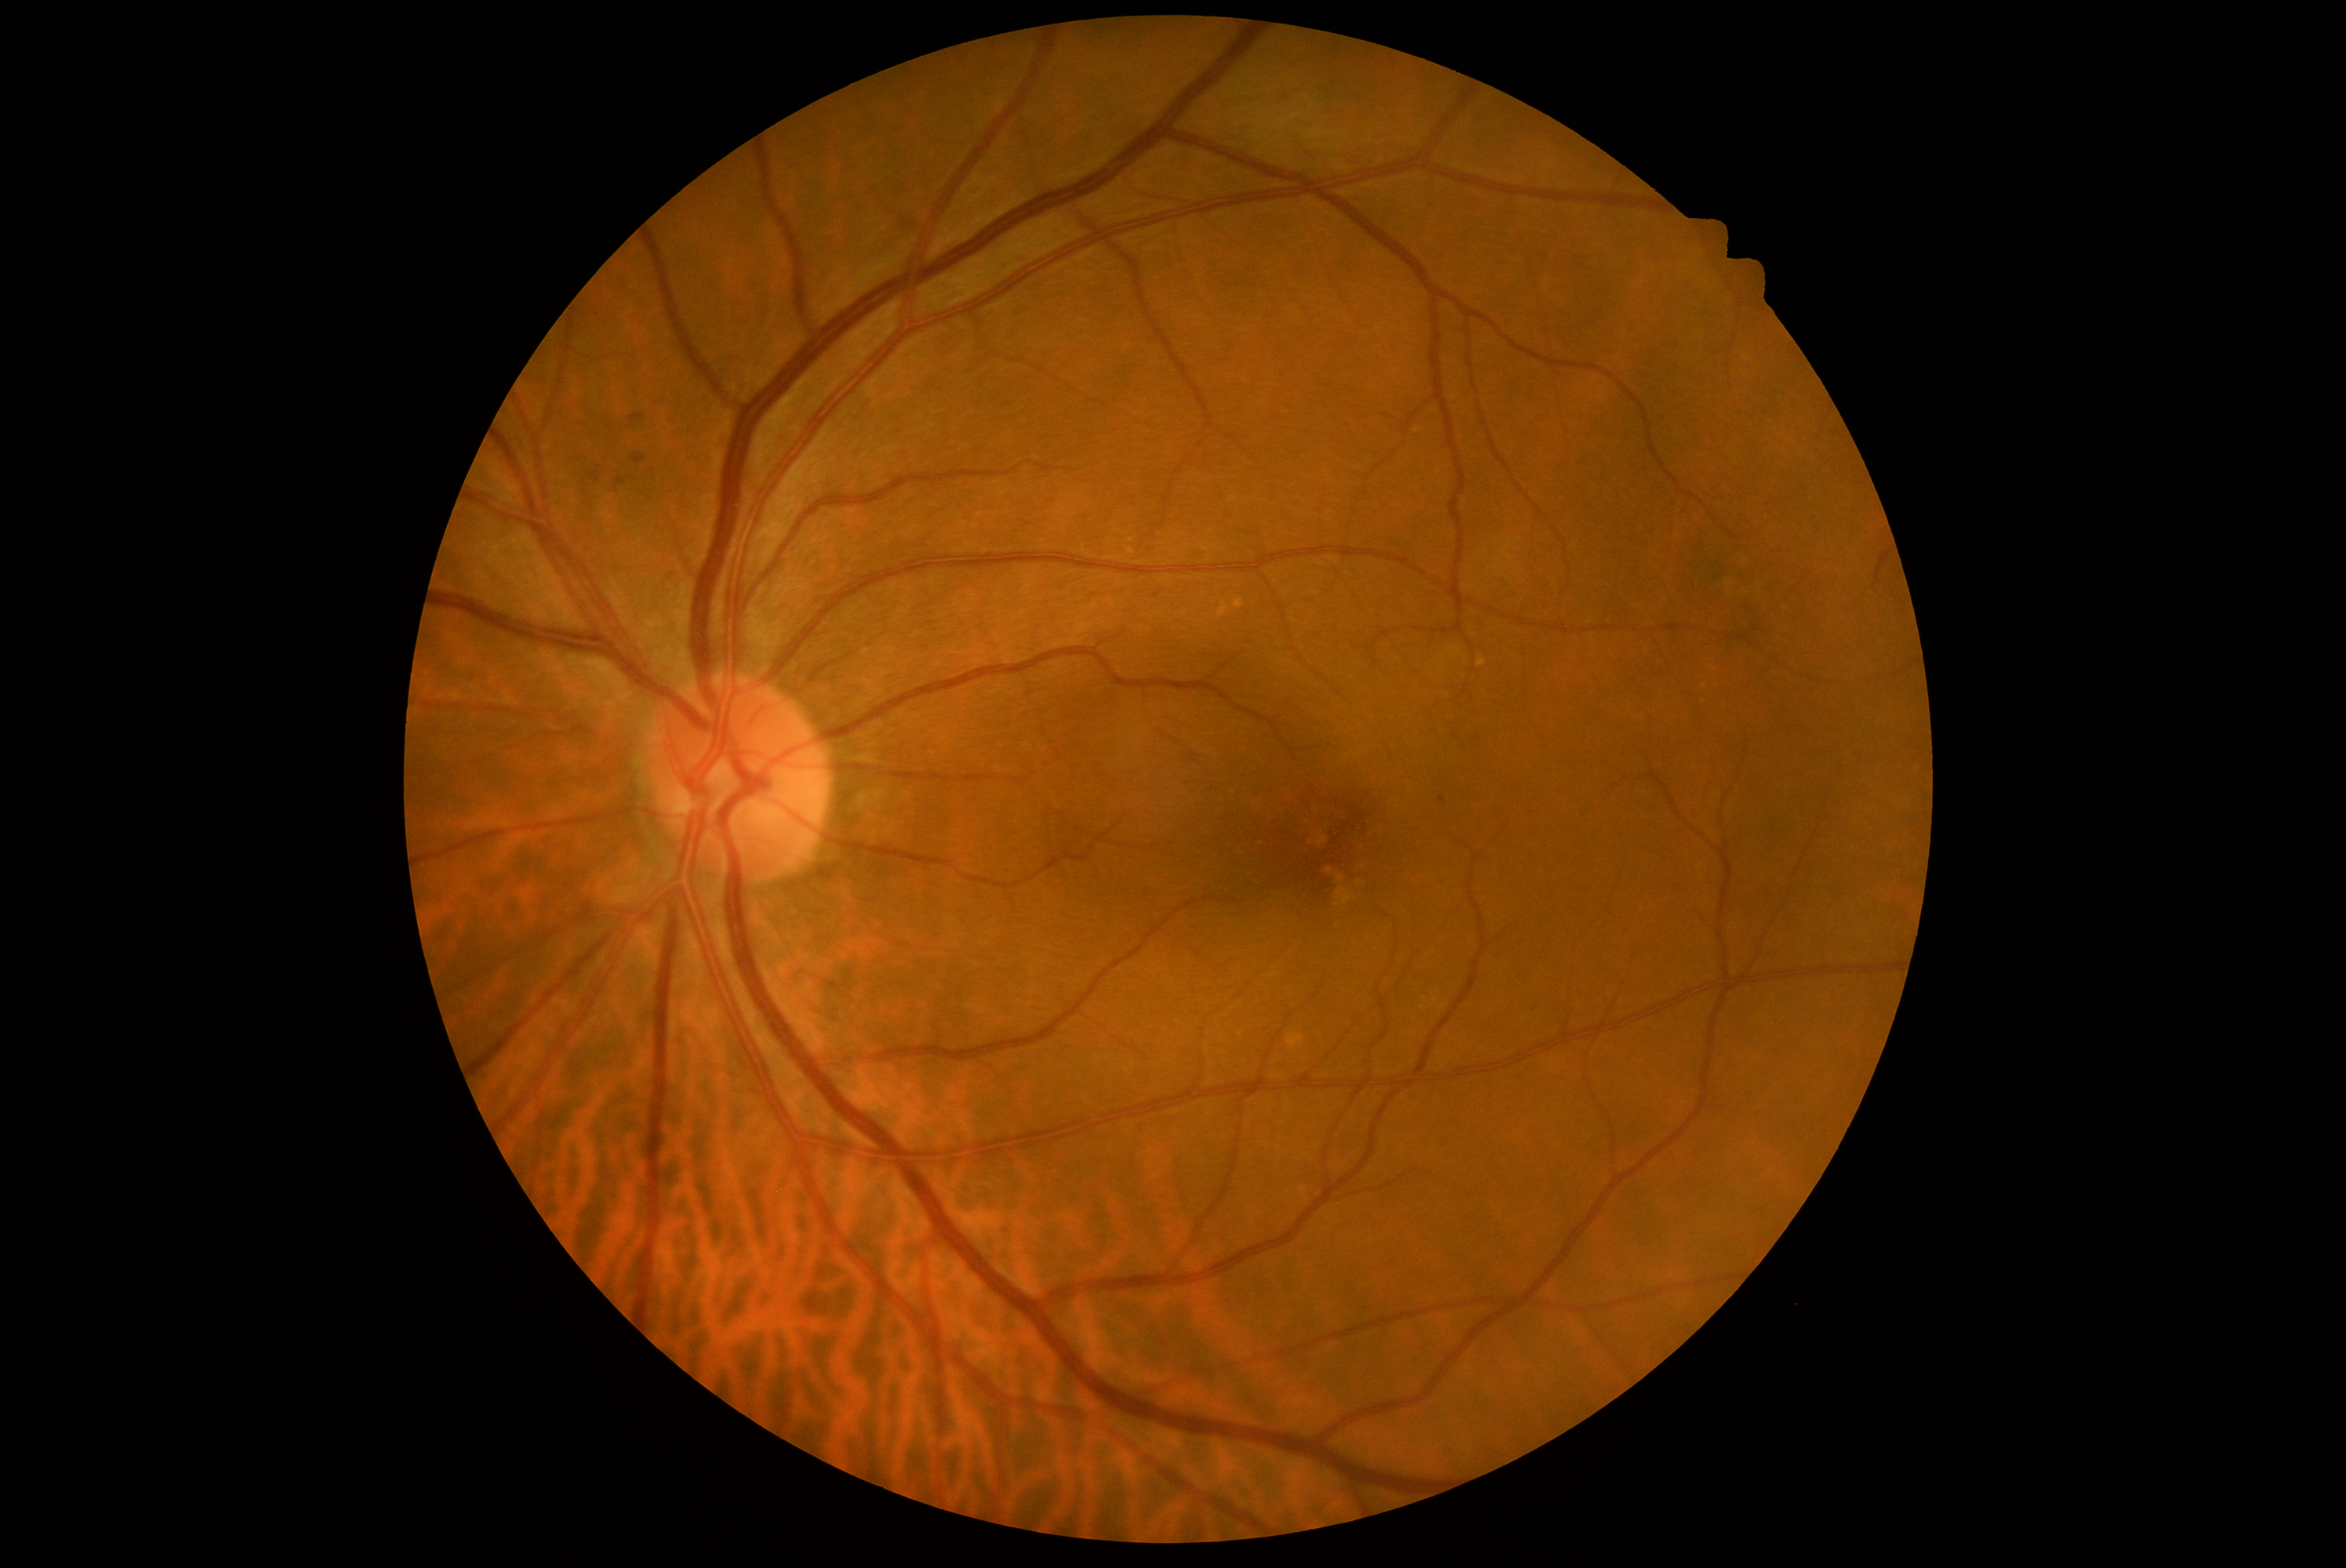
Diabetic retinopathy grade is 1.
Disease class: non-proliferative diabetic retinopathy.